Wide-field fundus photograph of an infant
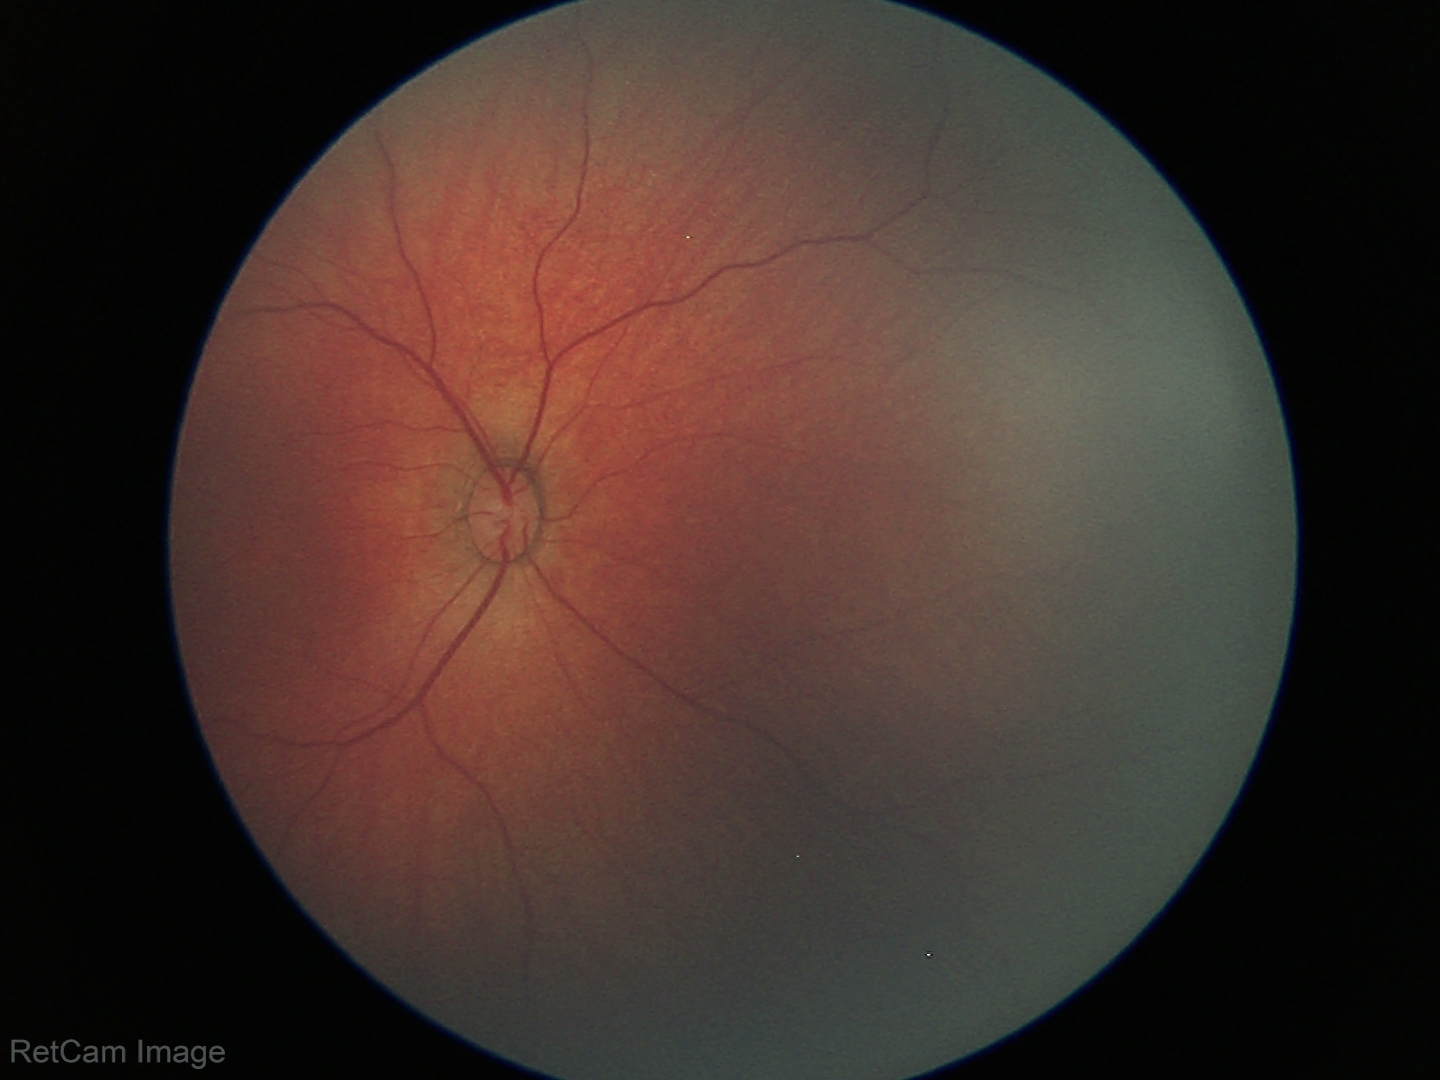 Normal screening examination.